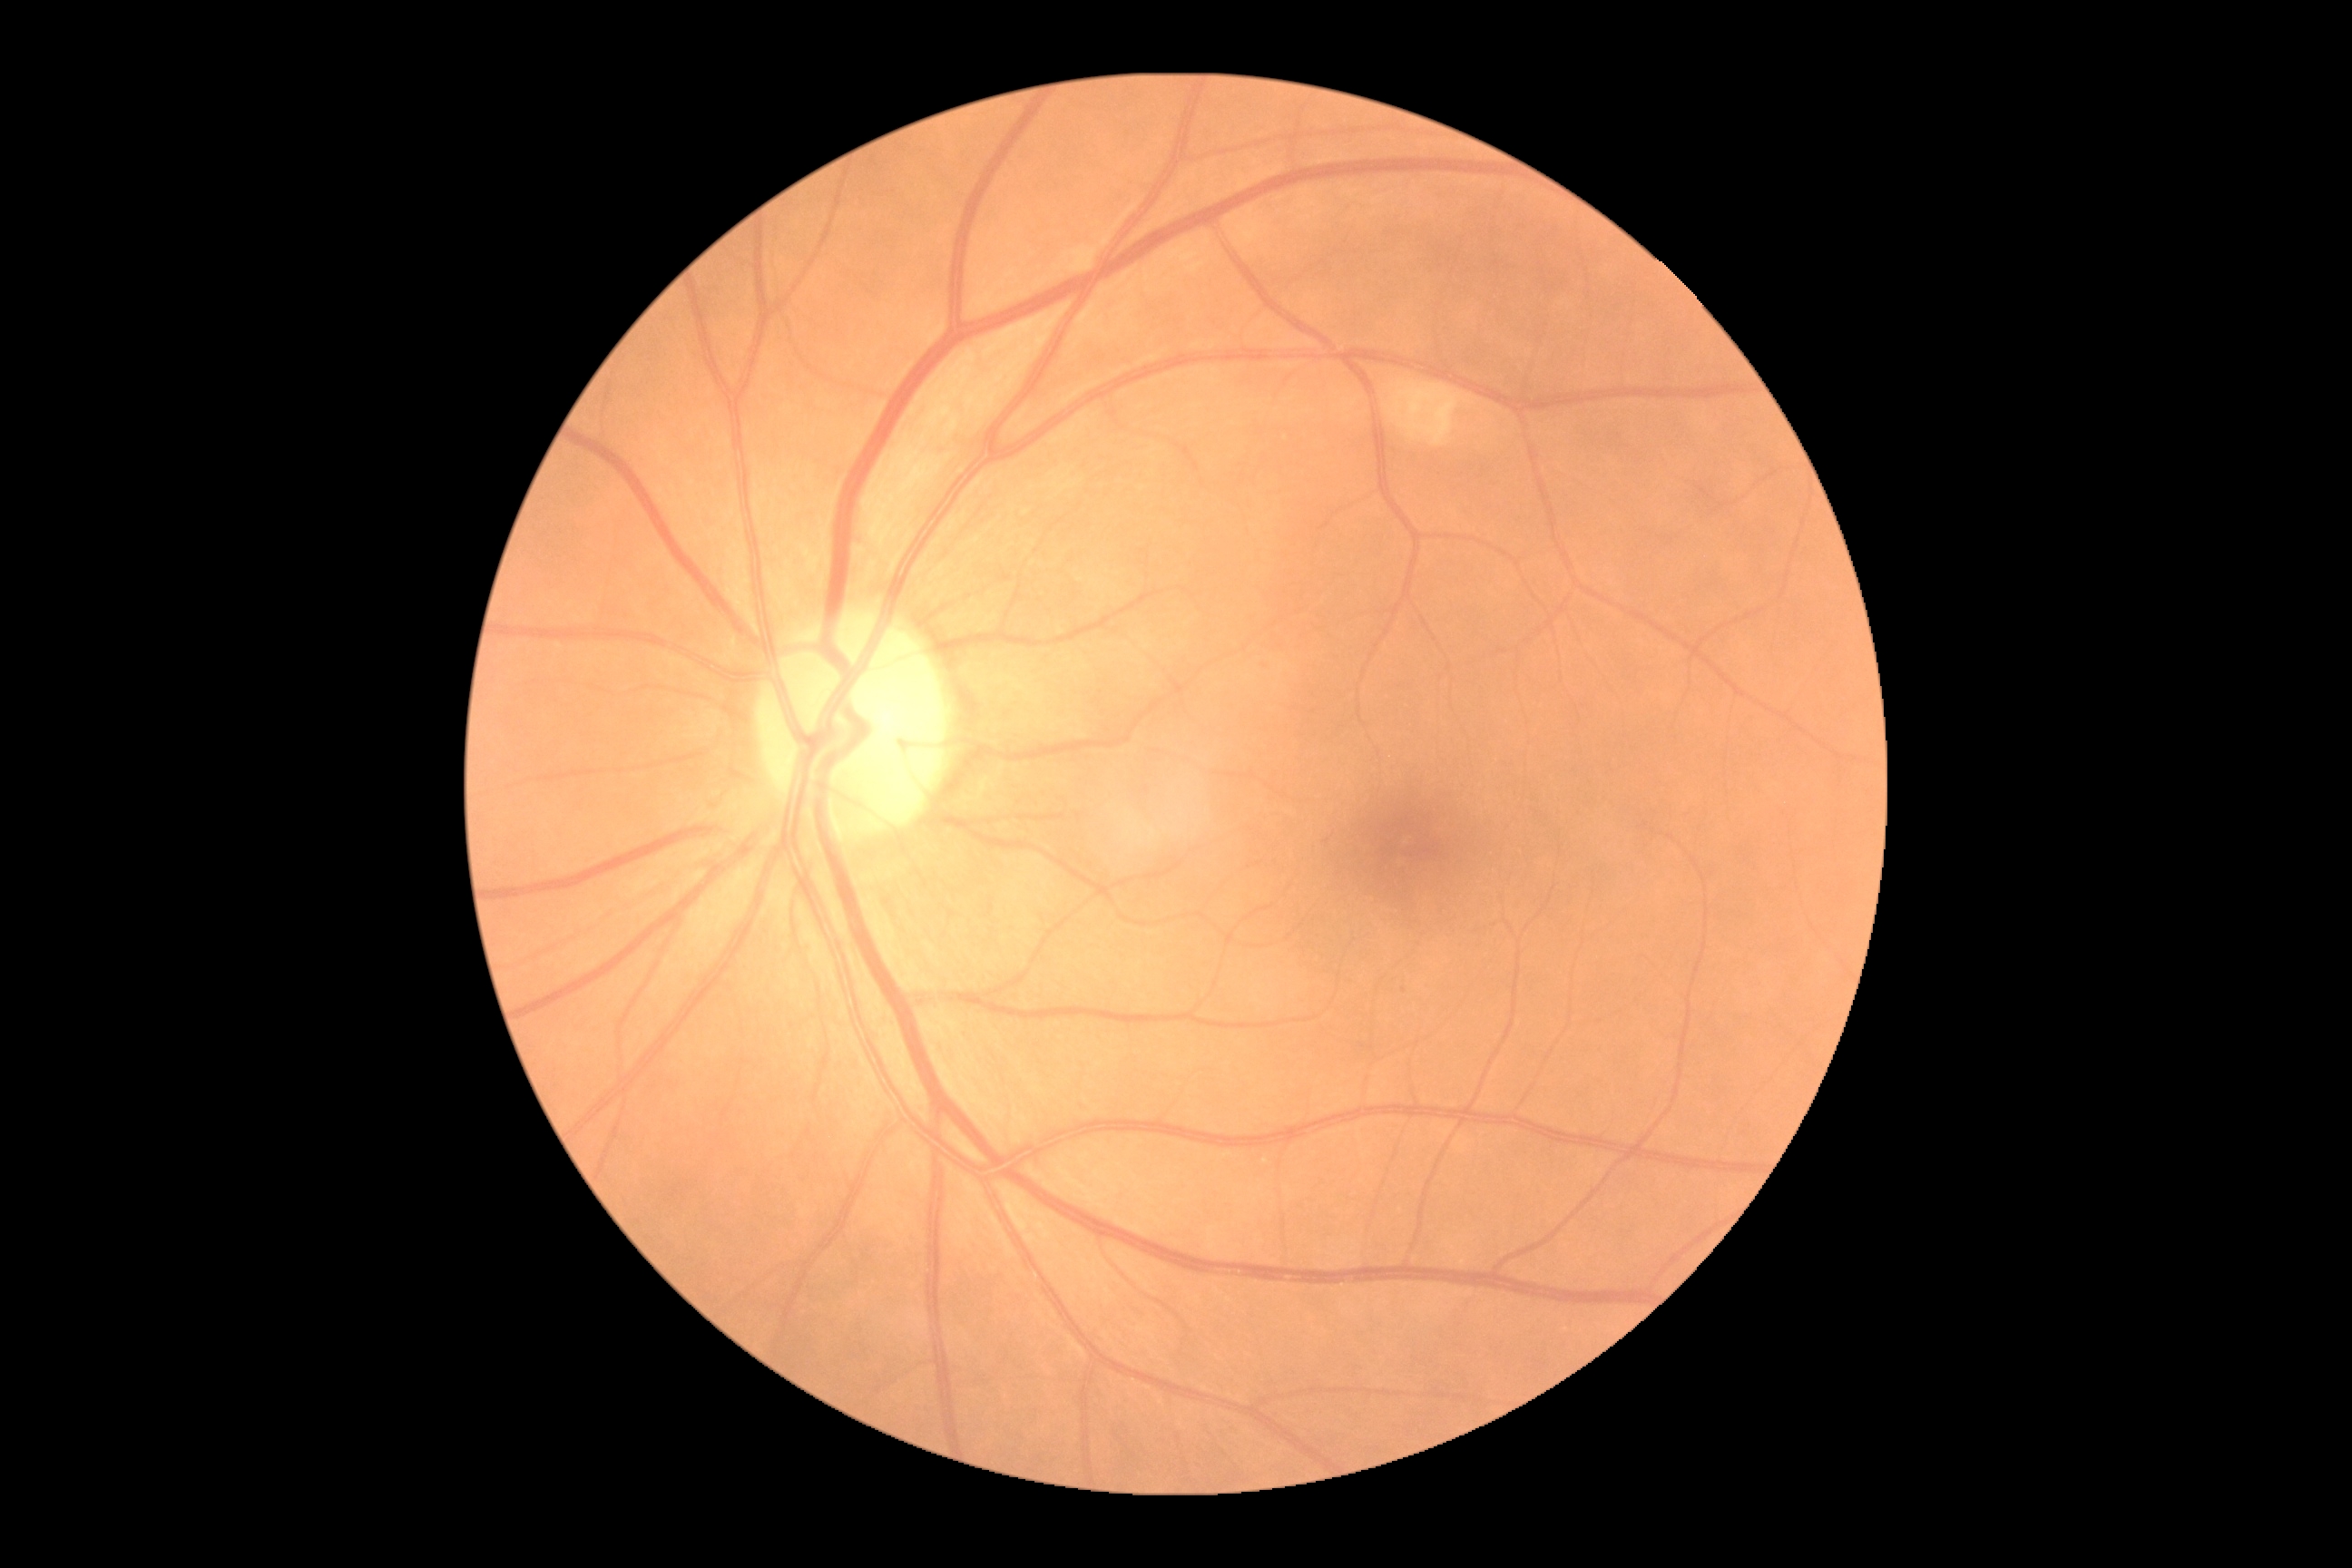
Diabetic retinopathy is 2/4.